Modified Davis grading: 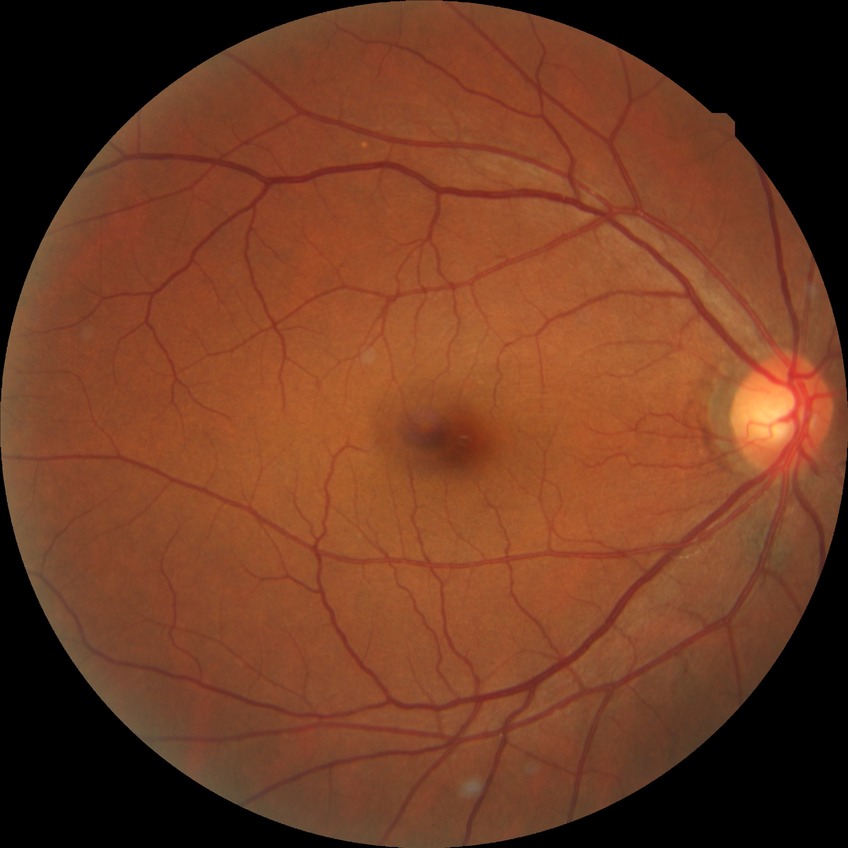

diabetic retinopathy stage: no diabetic retinopathy.